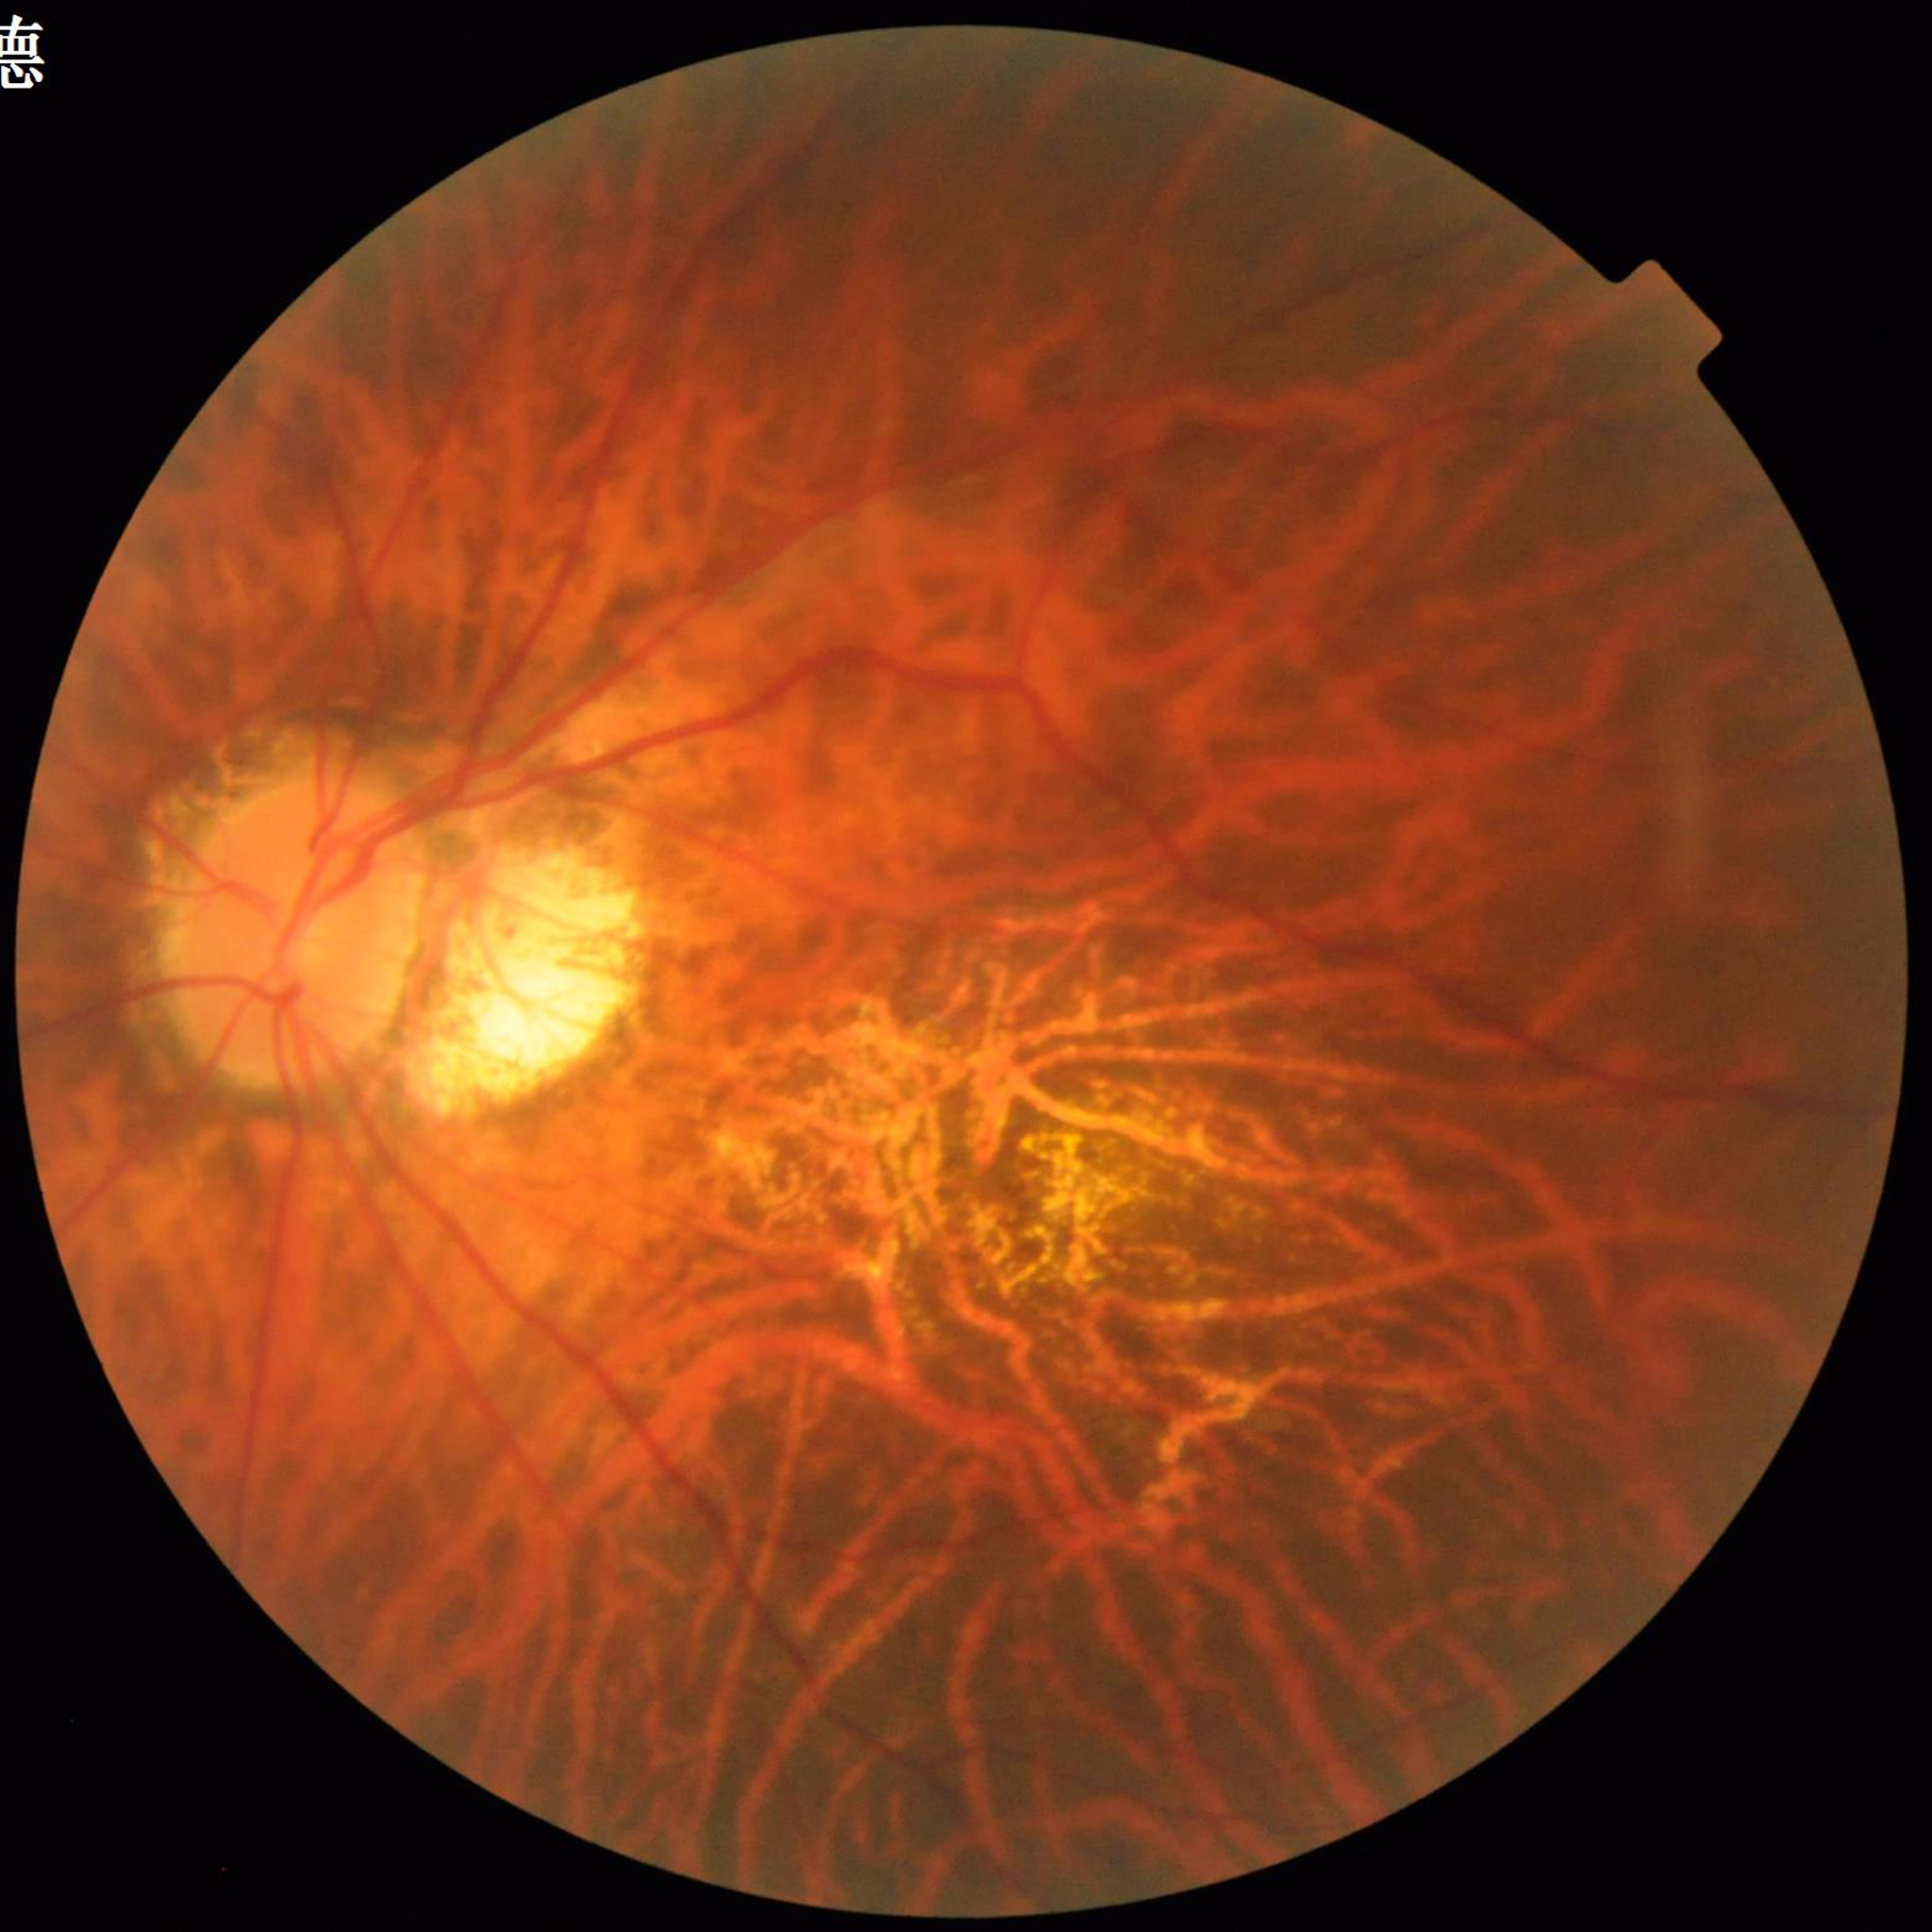
Clinical diagnosis = age-related macular degeneration
Quality = no quality issues identified